60° FOV; 2212 x 1659 pixels.
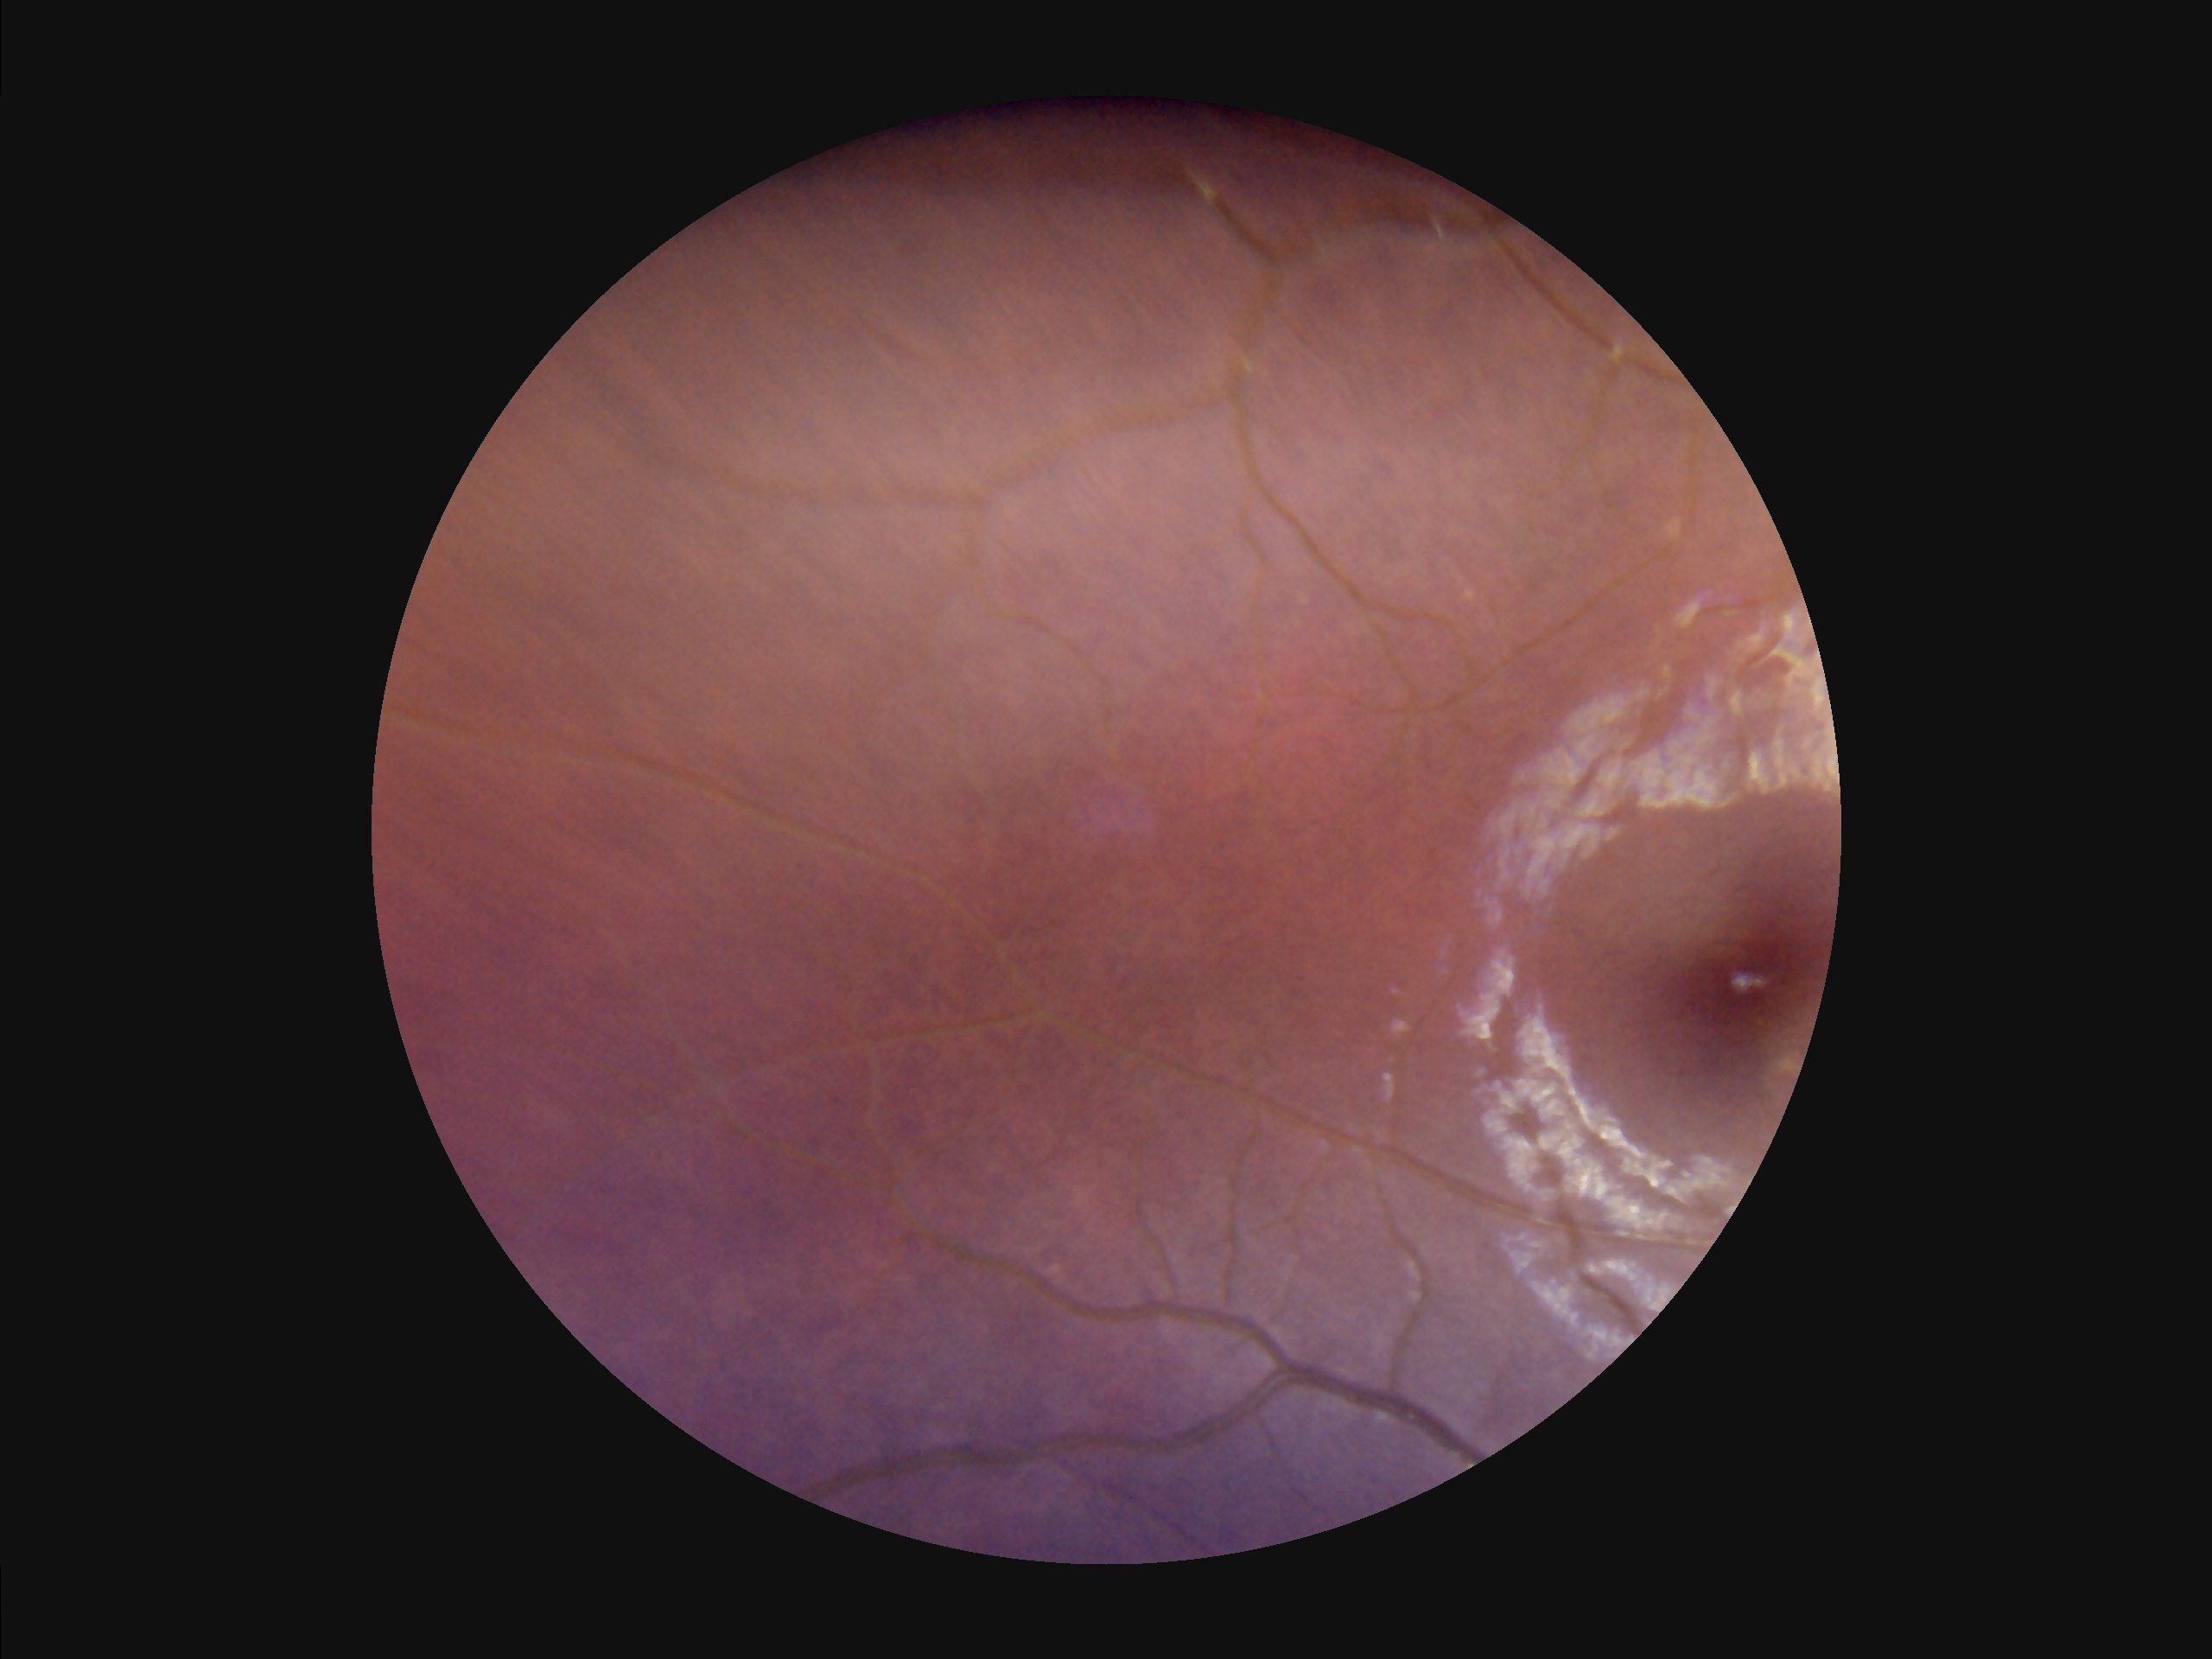

Poor dynamic range. The image is blurry. Overall image quality is poor. Poor illumination with uneven exposure.